848 x 848 pixels · acquired with a NIDEK AFC-230
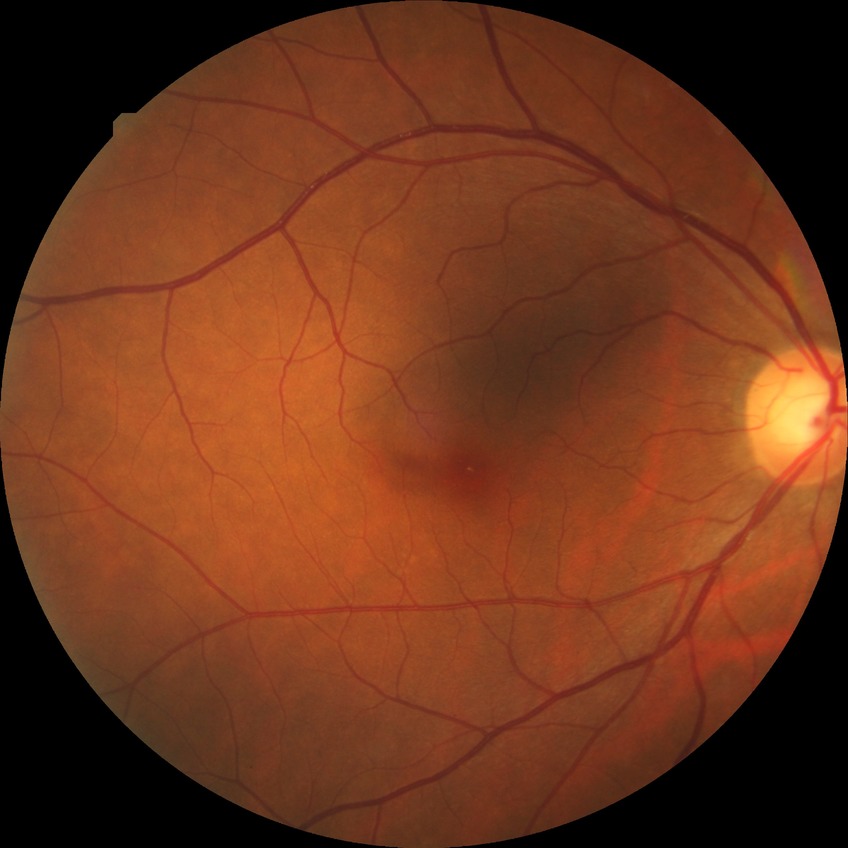

Diabetic retinopathy grade: no diabetic retinopathy.